2228x1652px
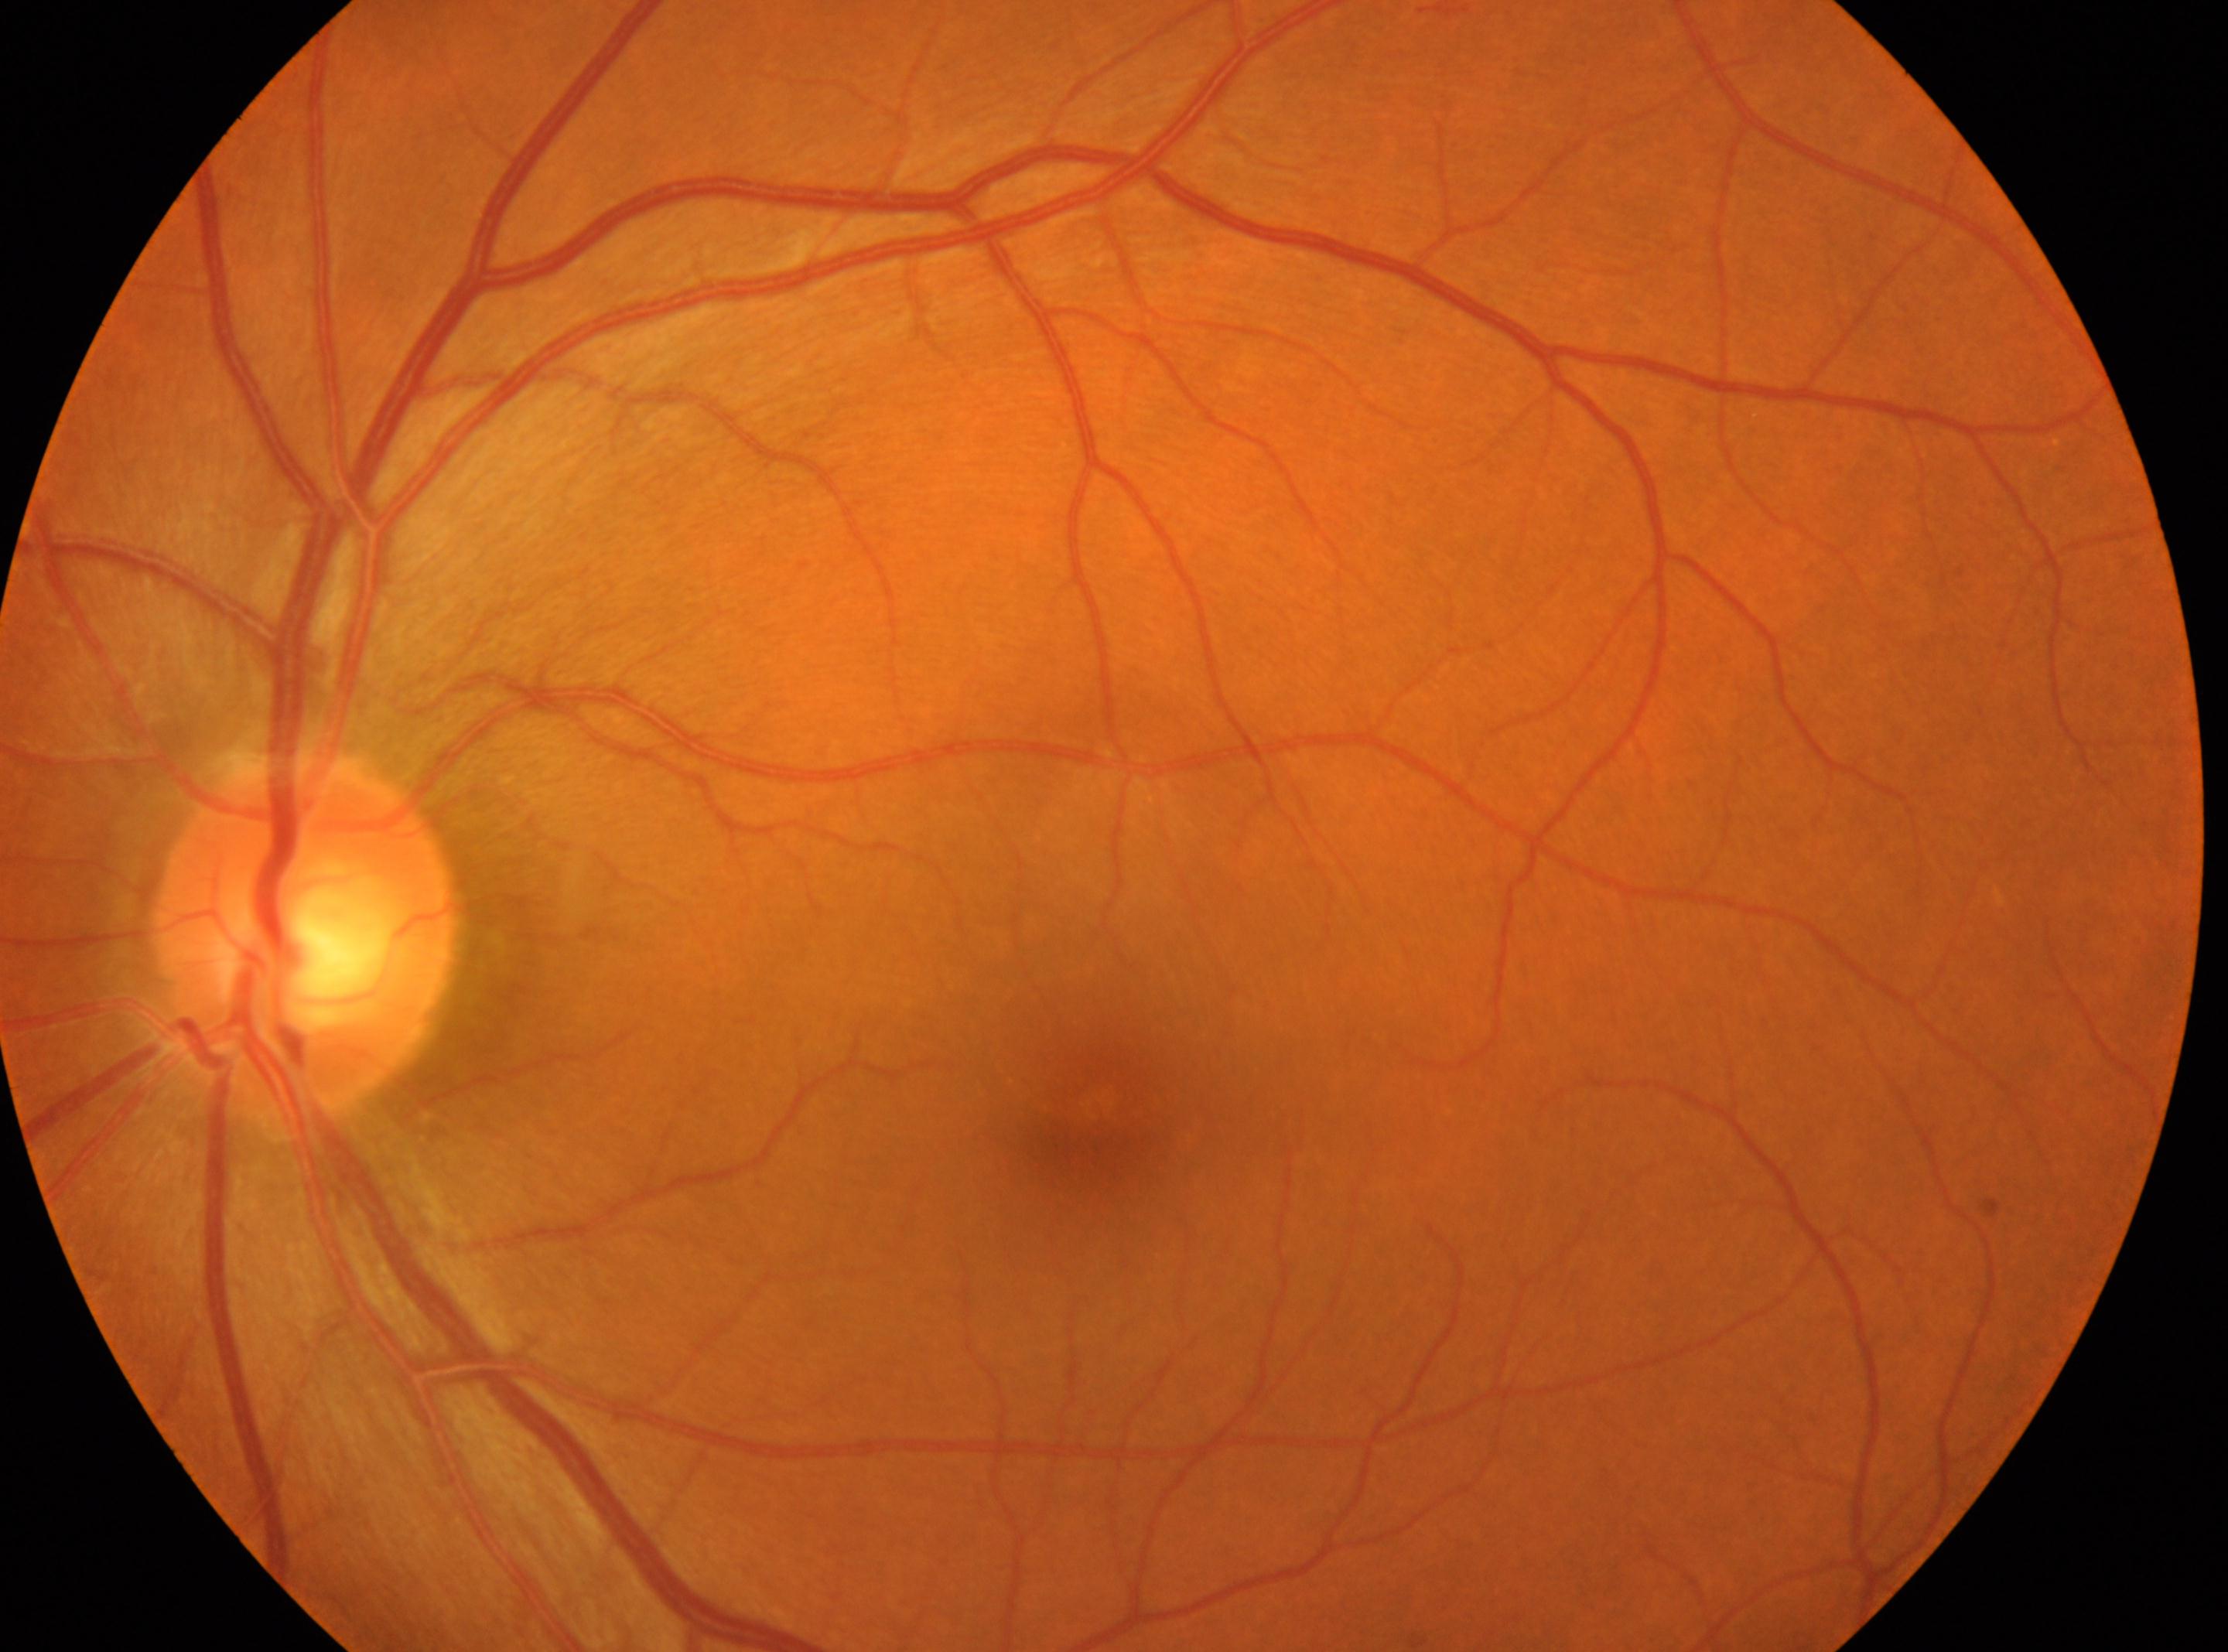

  eye: the left eye
  fovea: (x: 1085, y: 1126)
  optic_disc: (x: 306, y: 939)
  dr_grade: 0 — no visible signs of diabetic retinopathy